Wide-field fundus photograph of an infant.
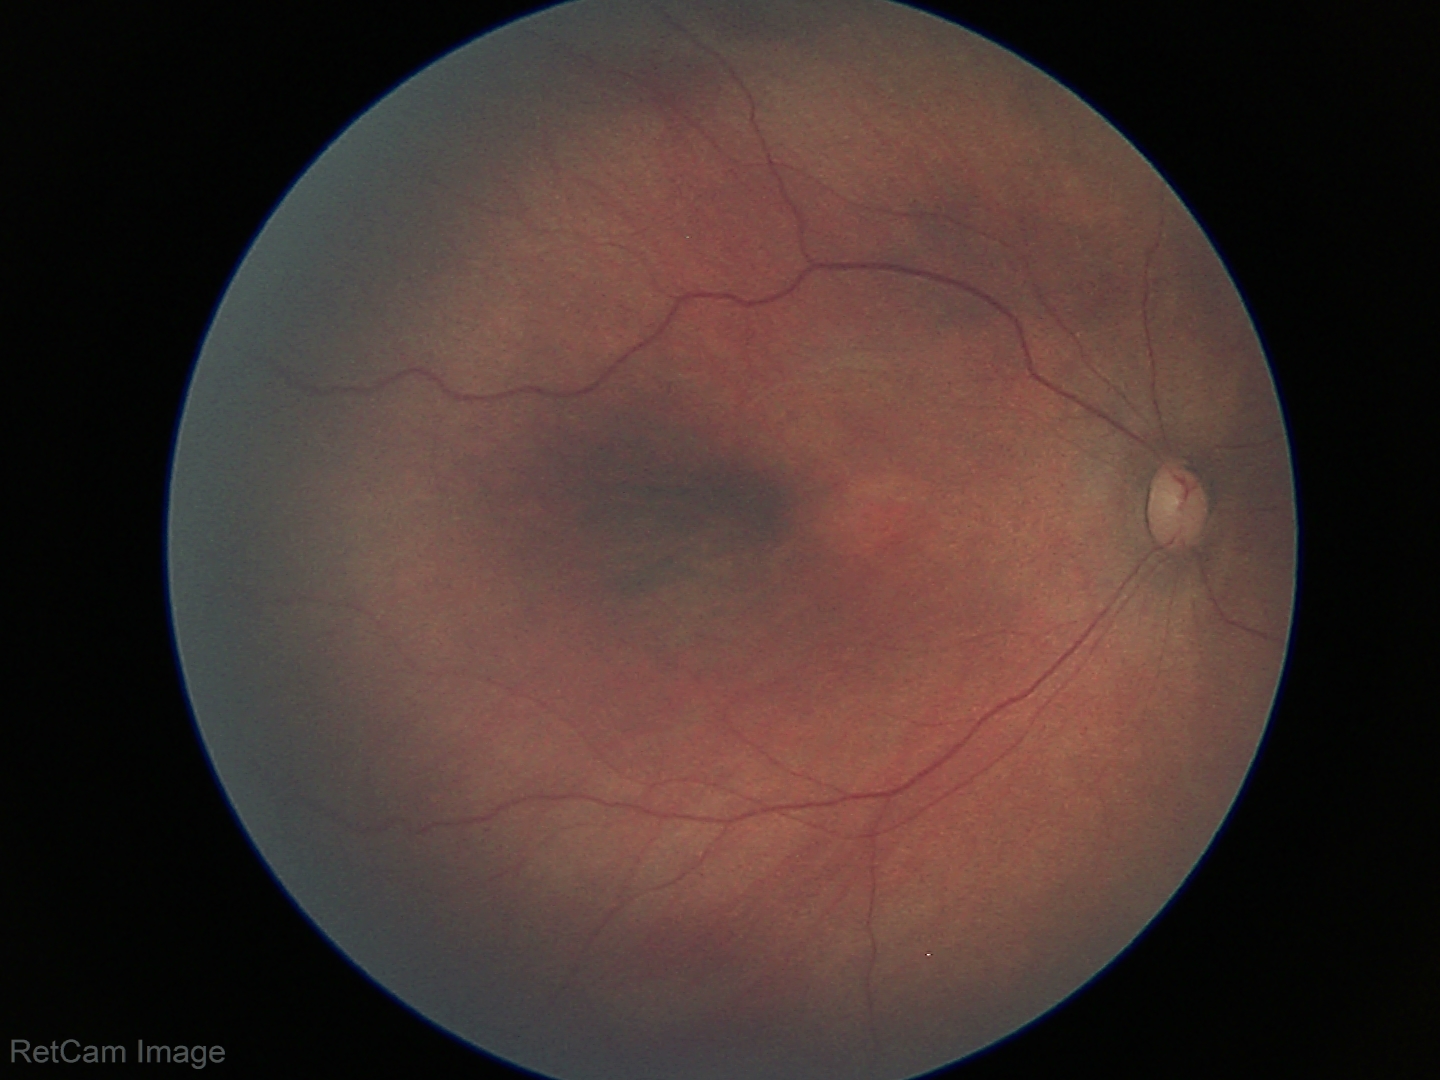 Assessment: physiological appearance with no retinal pathology.